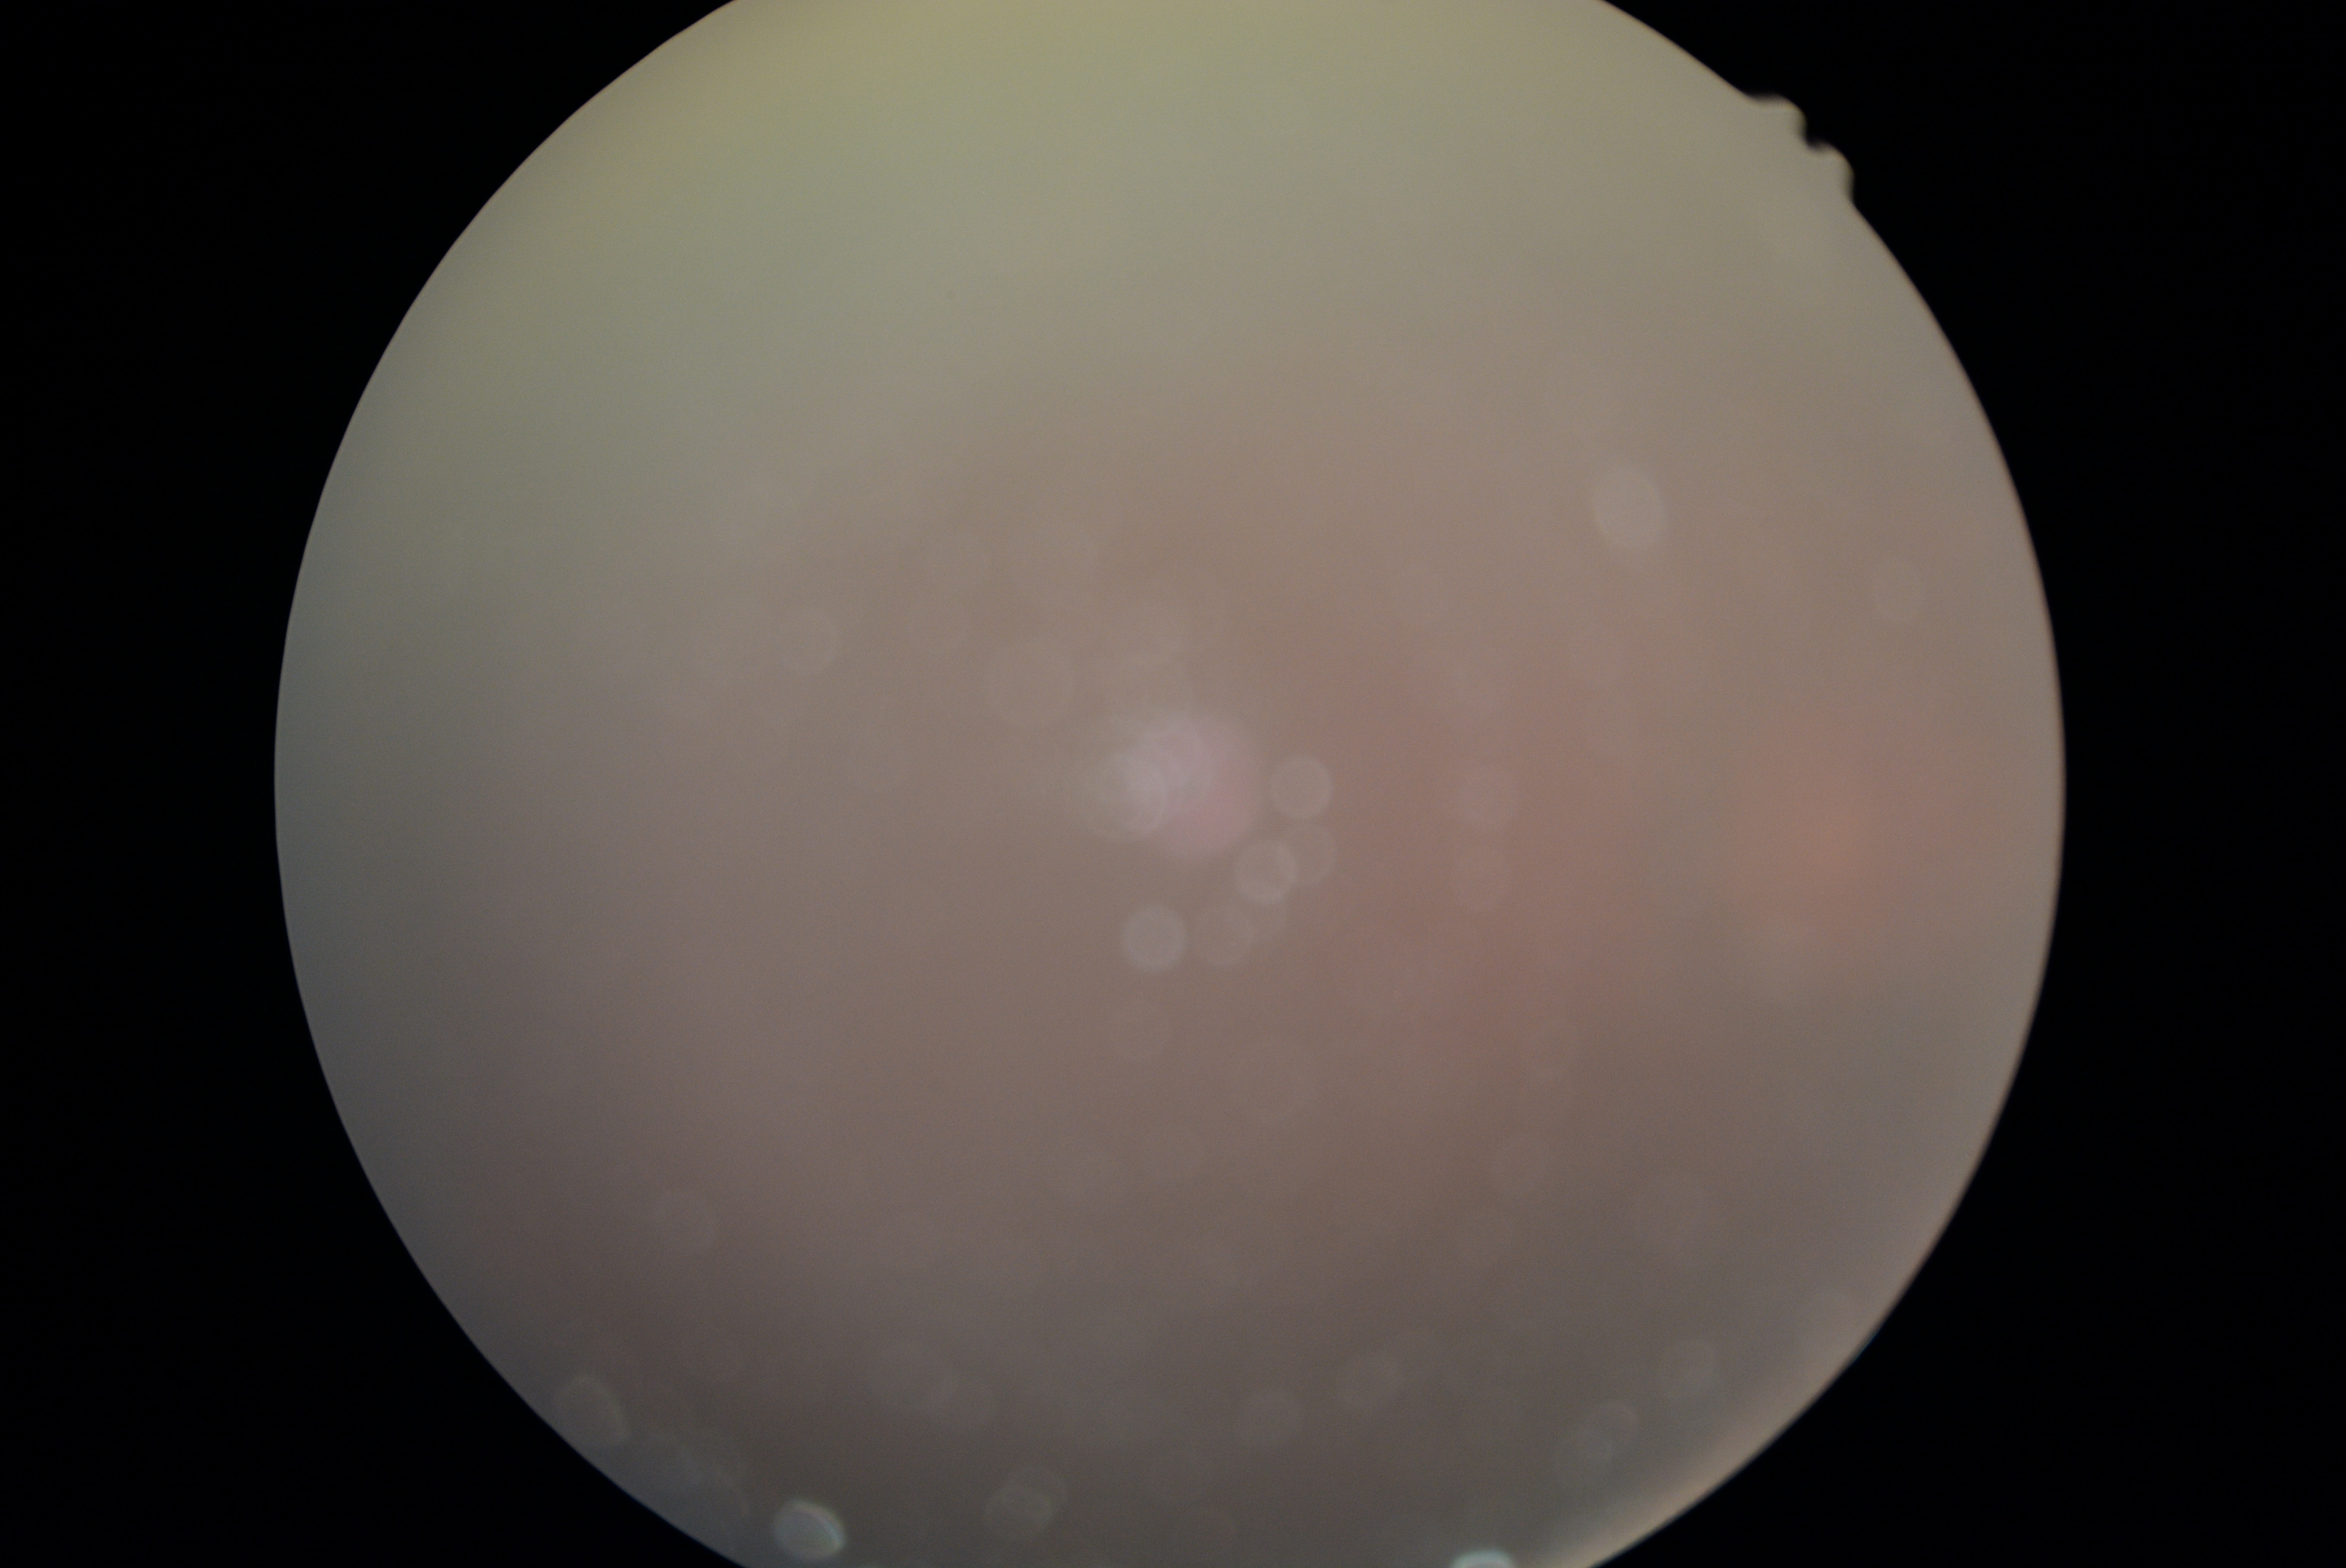
Quality too poor to assess for DR.
DR grade is ungradable.